100° field of view (Phoenix ICON). 1240 x 1240 pixels. Wide-field contact fundus photograph of an infant — 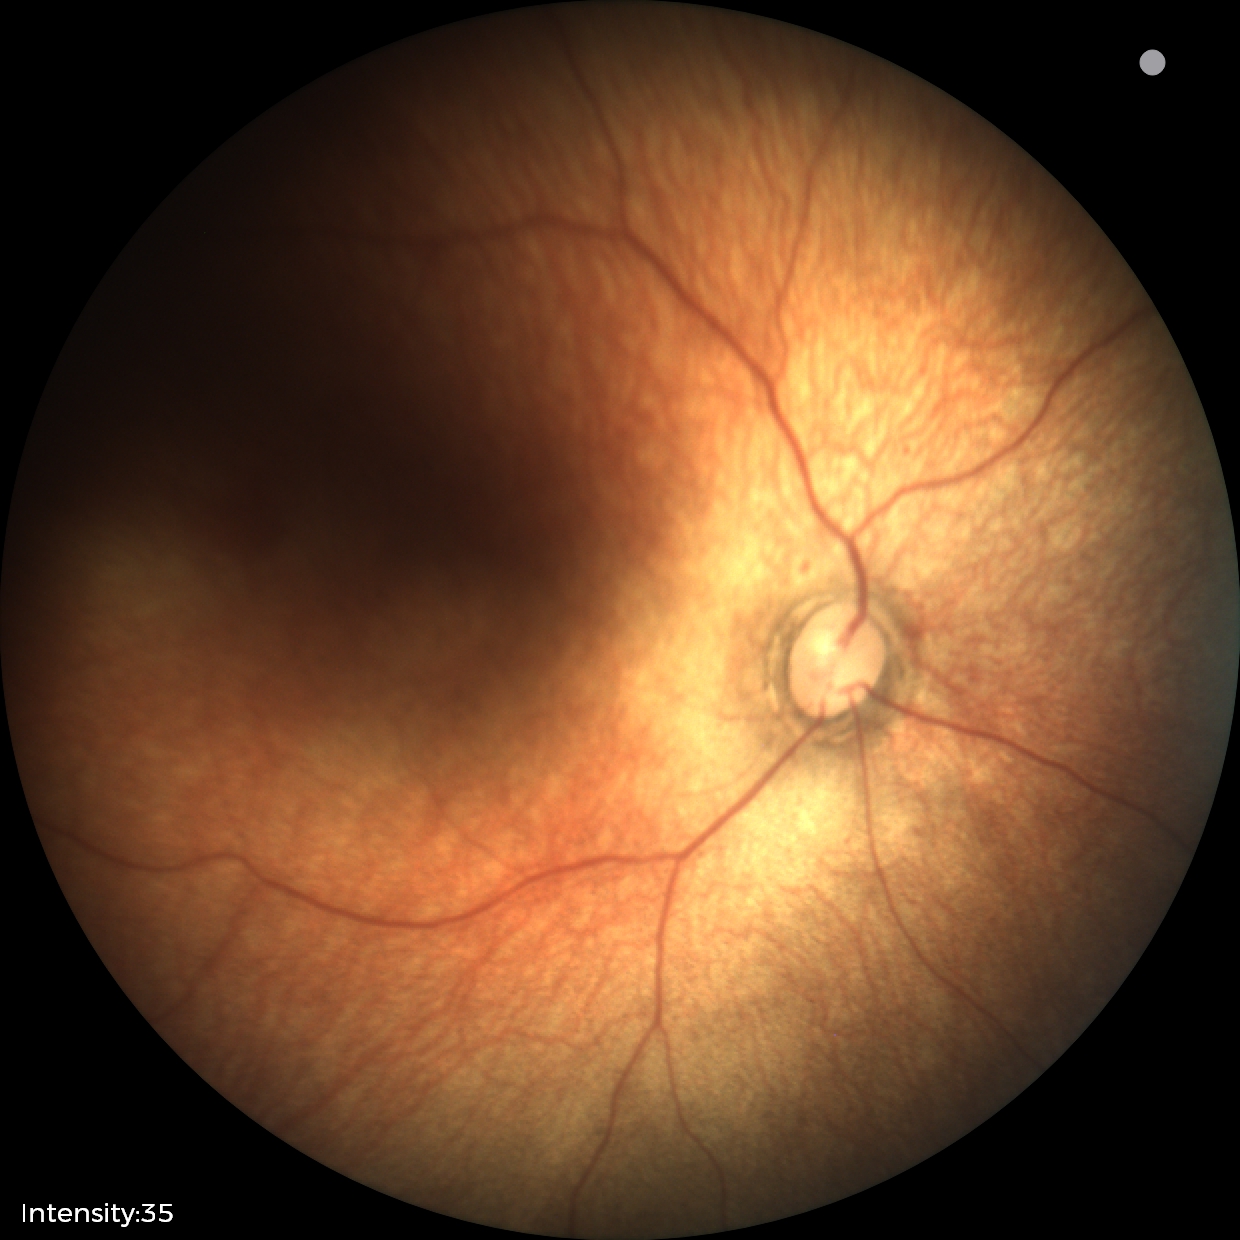

Normal screening examination.